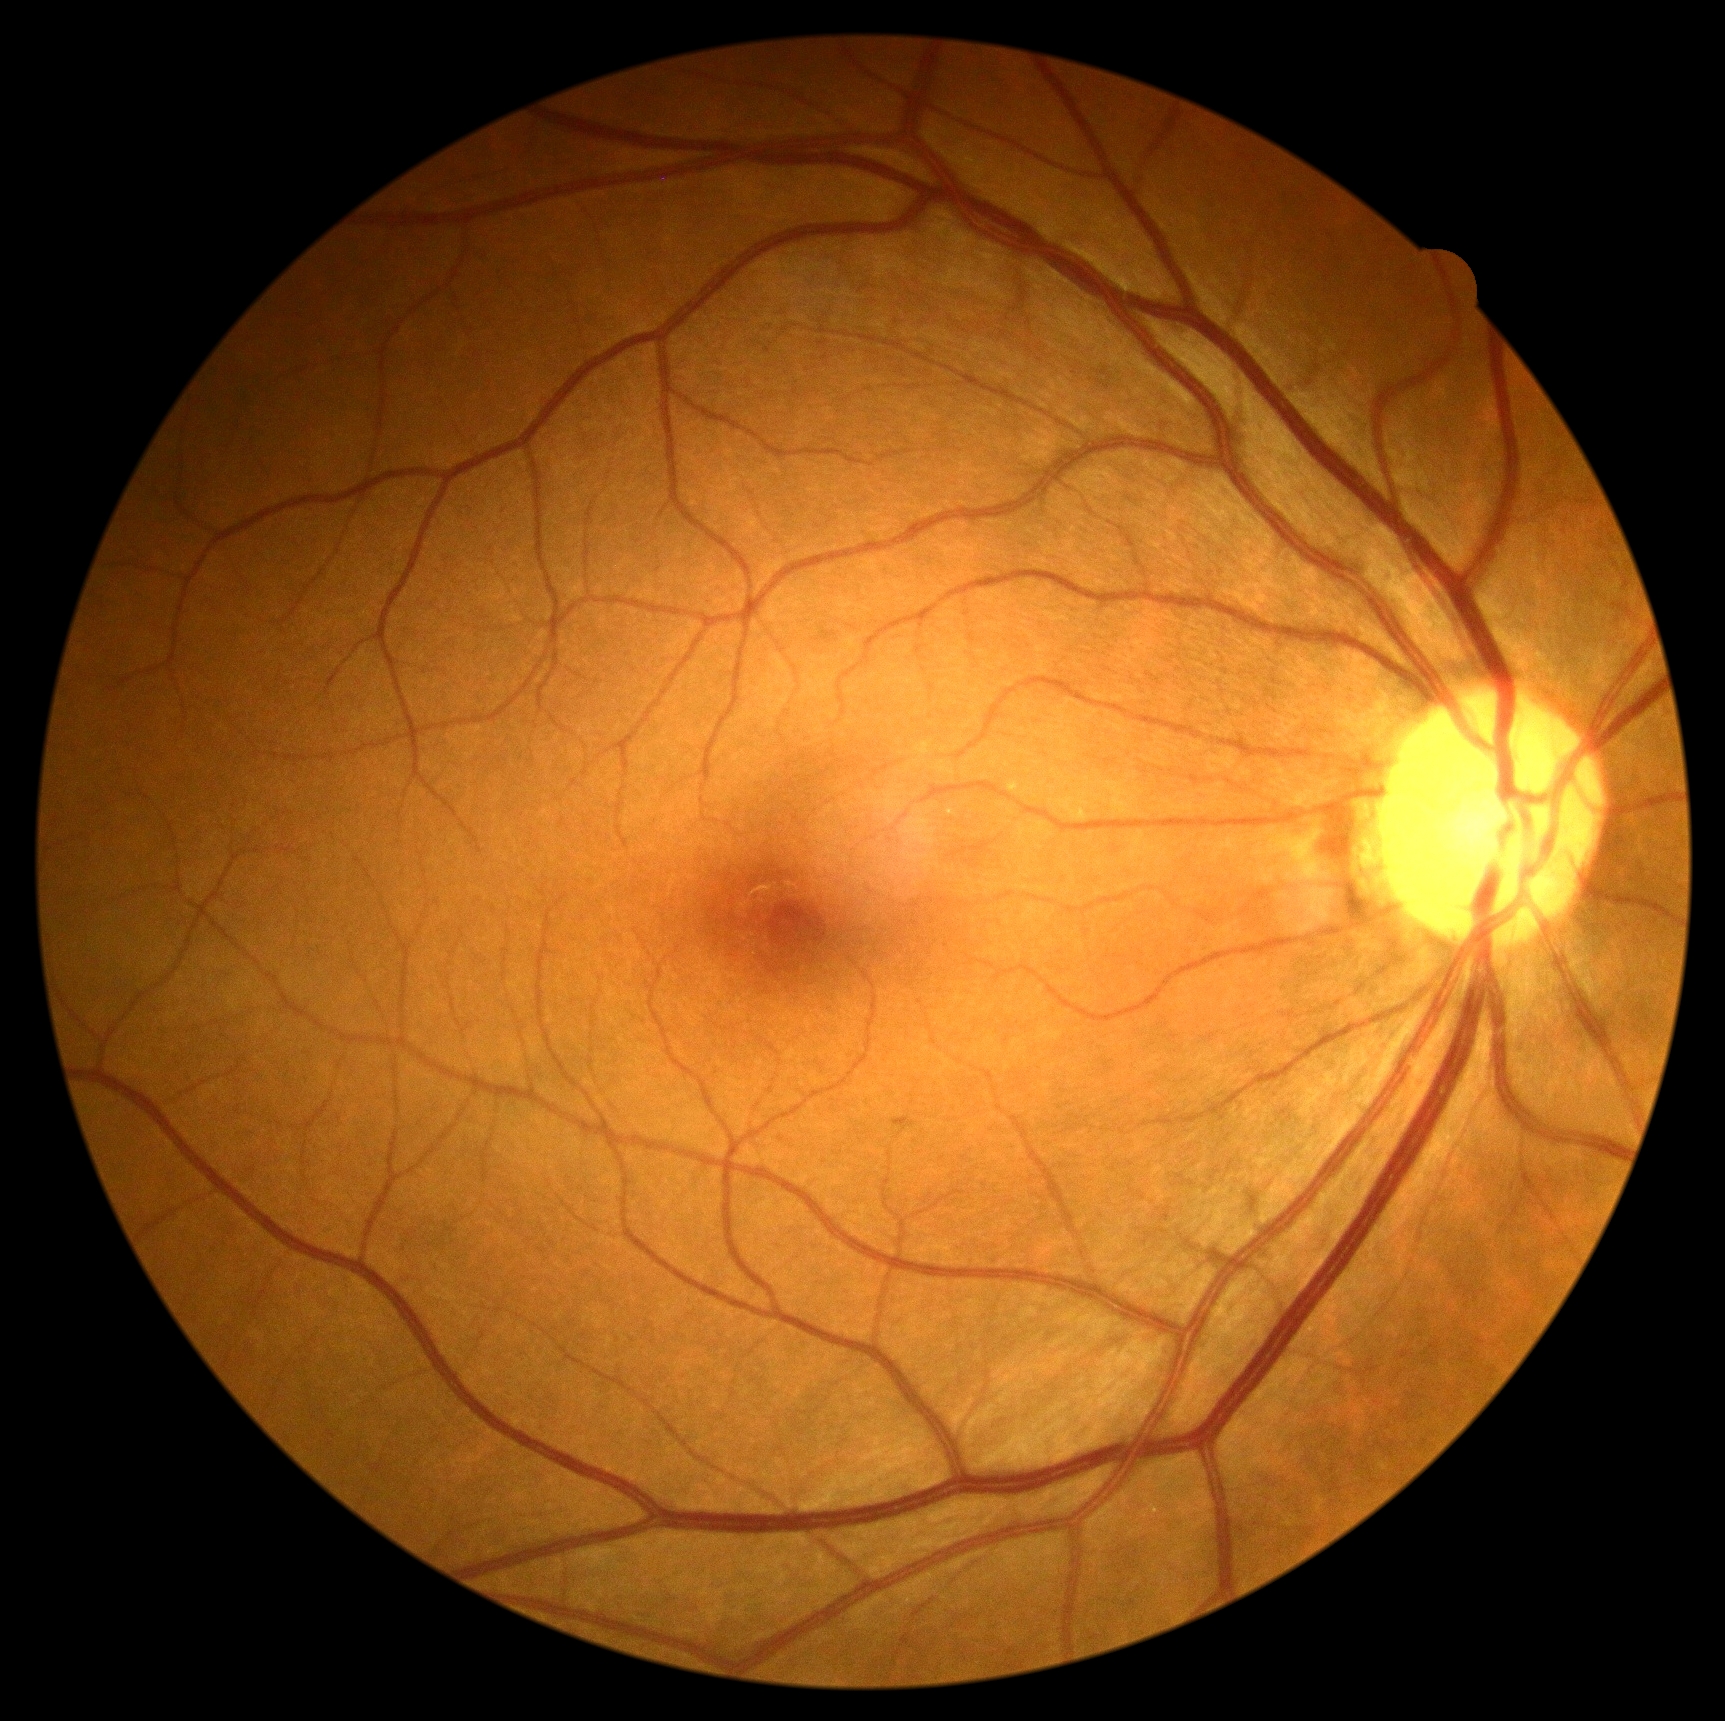

DR grade: no apparent diabetic retinopathy (0).